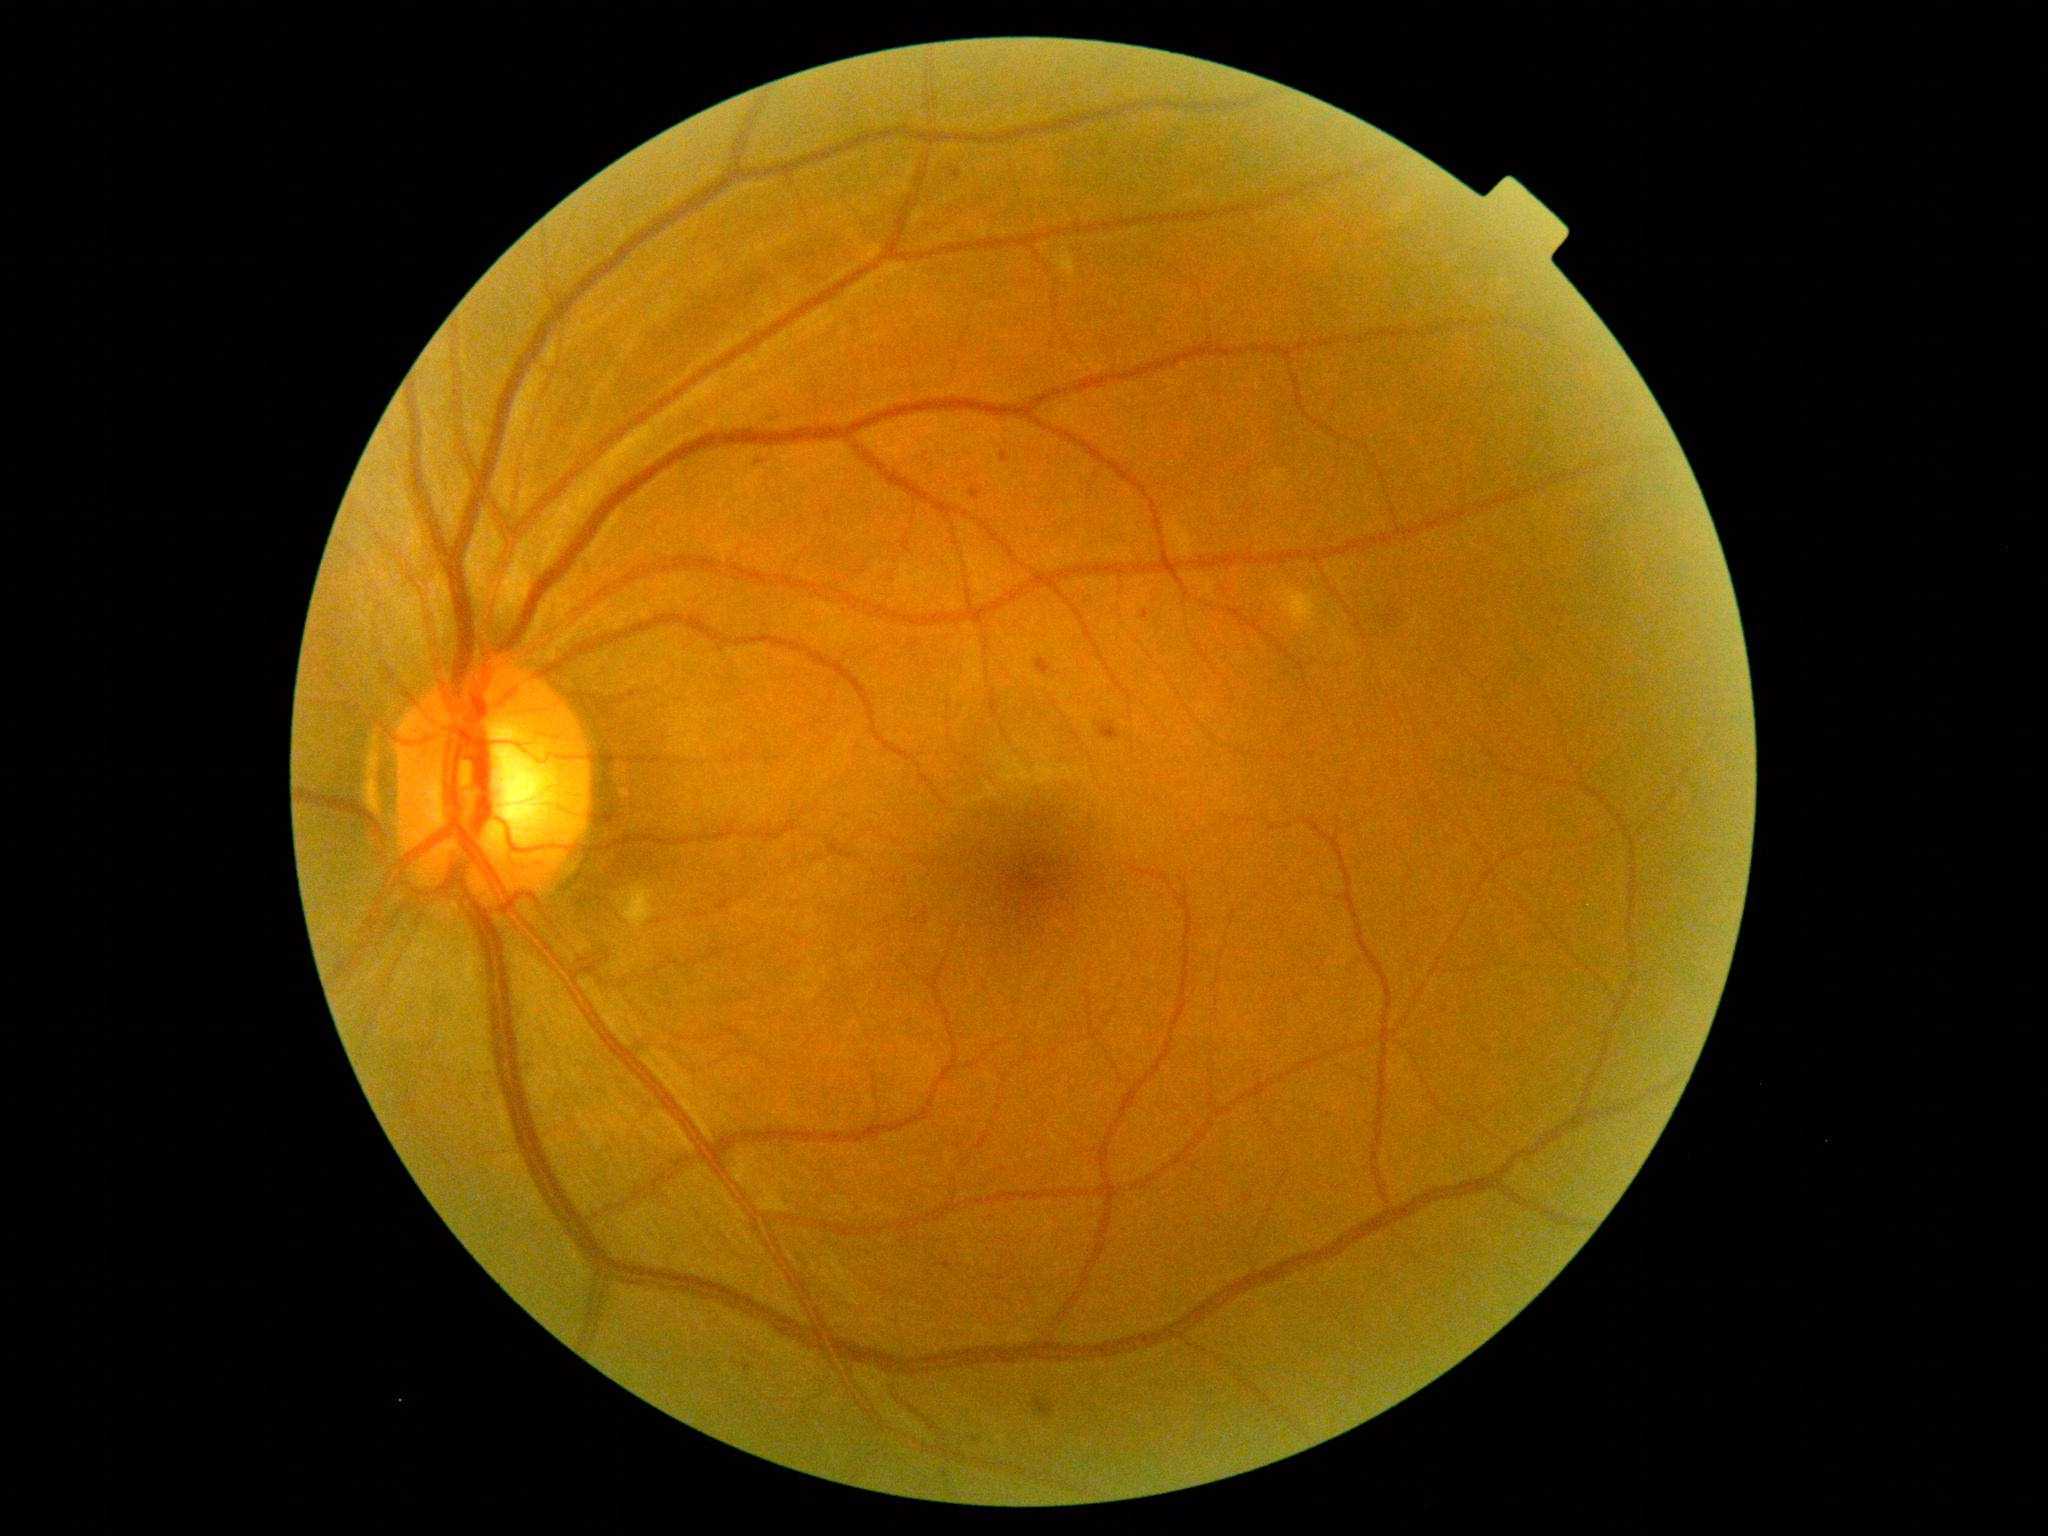
dr_grade: 2
lesions:
  ex: []
  ma:
    - <box>743,1364,751,1372</box>
    - <box>952,170,961,180</box>
    - <box>970,487,984,502</box>
    - <box>1140,611,1149,621</box>
    - <box>822,507,832,523</box>
    - <box>770,416,776,426</box>
    - <box>1001,453,1010,463</box>
  ma_small_centers:
    - [758, 462]
  se:
    - <box>625,889,658,931</box>
    - <box>1275,583,1318,627</box>
    - <box>1054,248,1076,279</box>
  he:
    - <box>1030,1397,1056,1420</box>
    - <box>1037,659,1051,675</box>
    - <box>1097,723,1122,740</box>
    - <box>1374,605,1404,629</box>